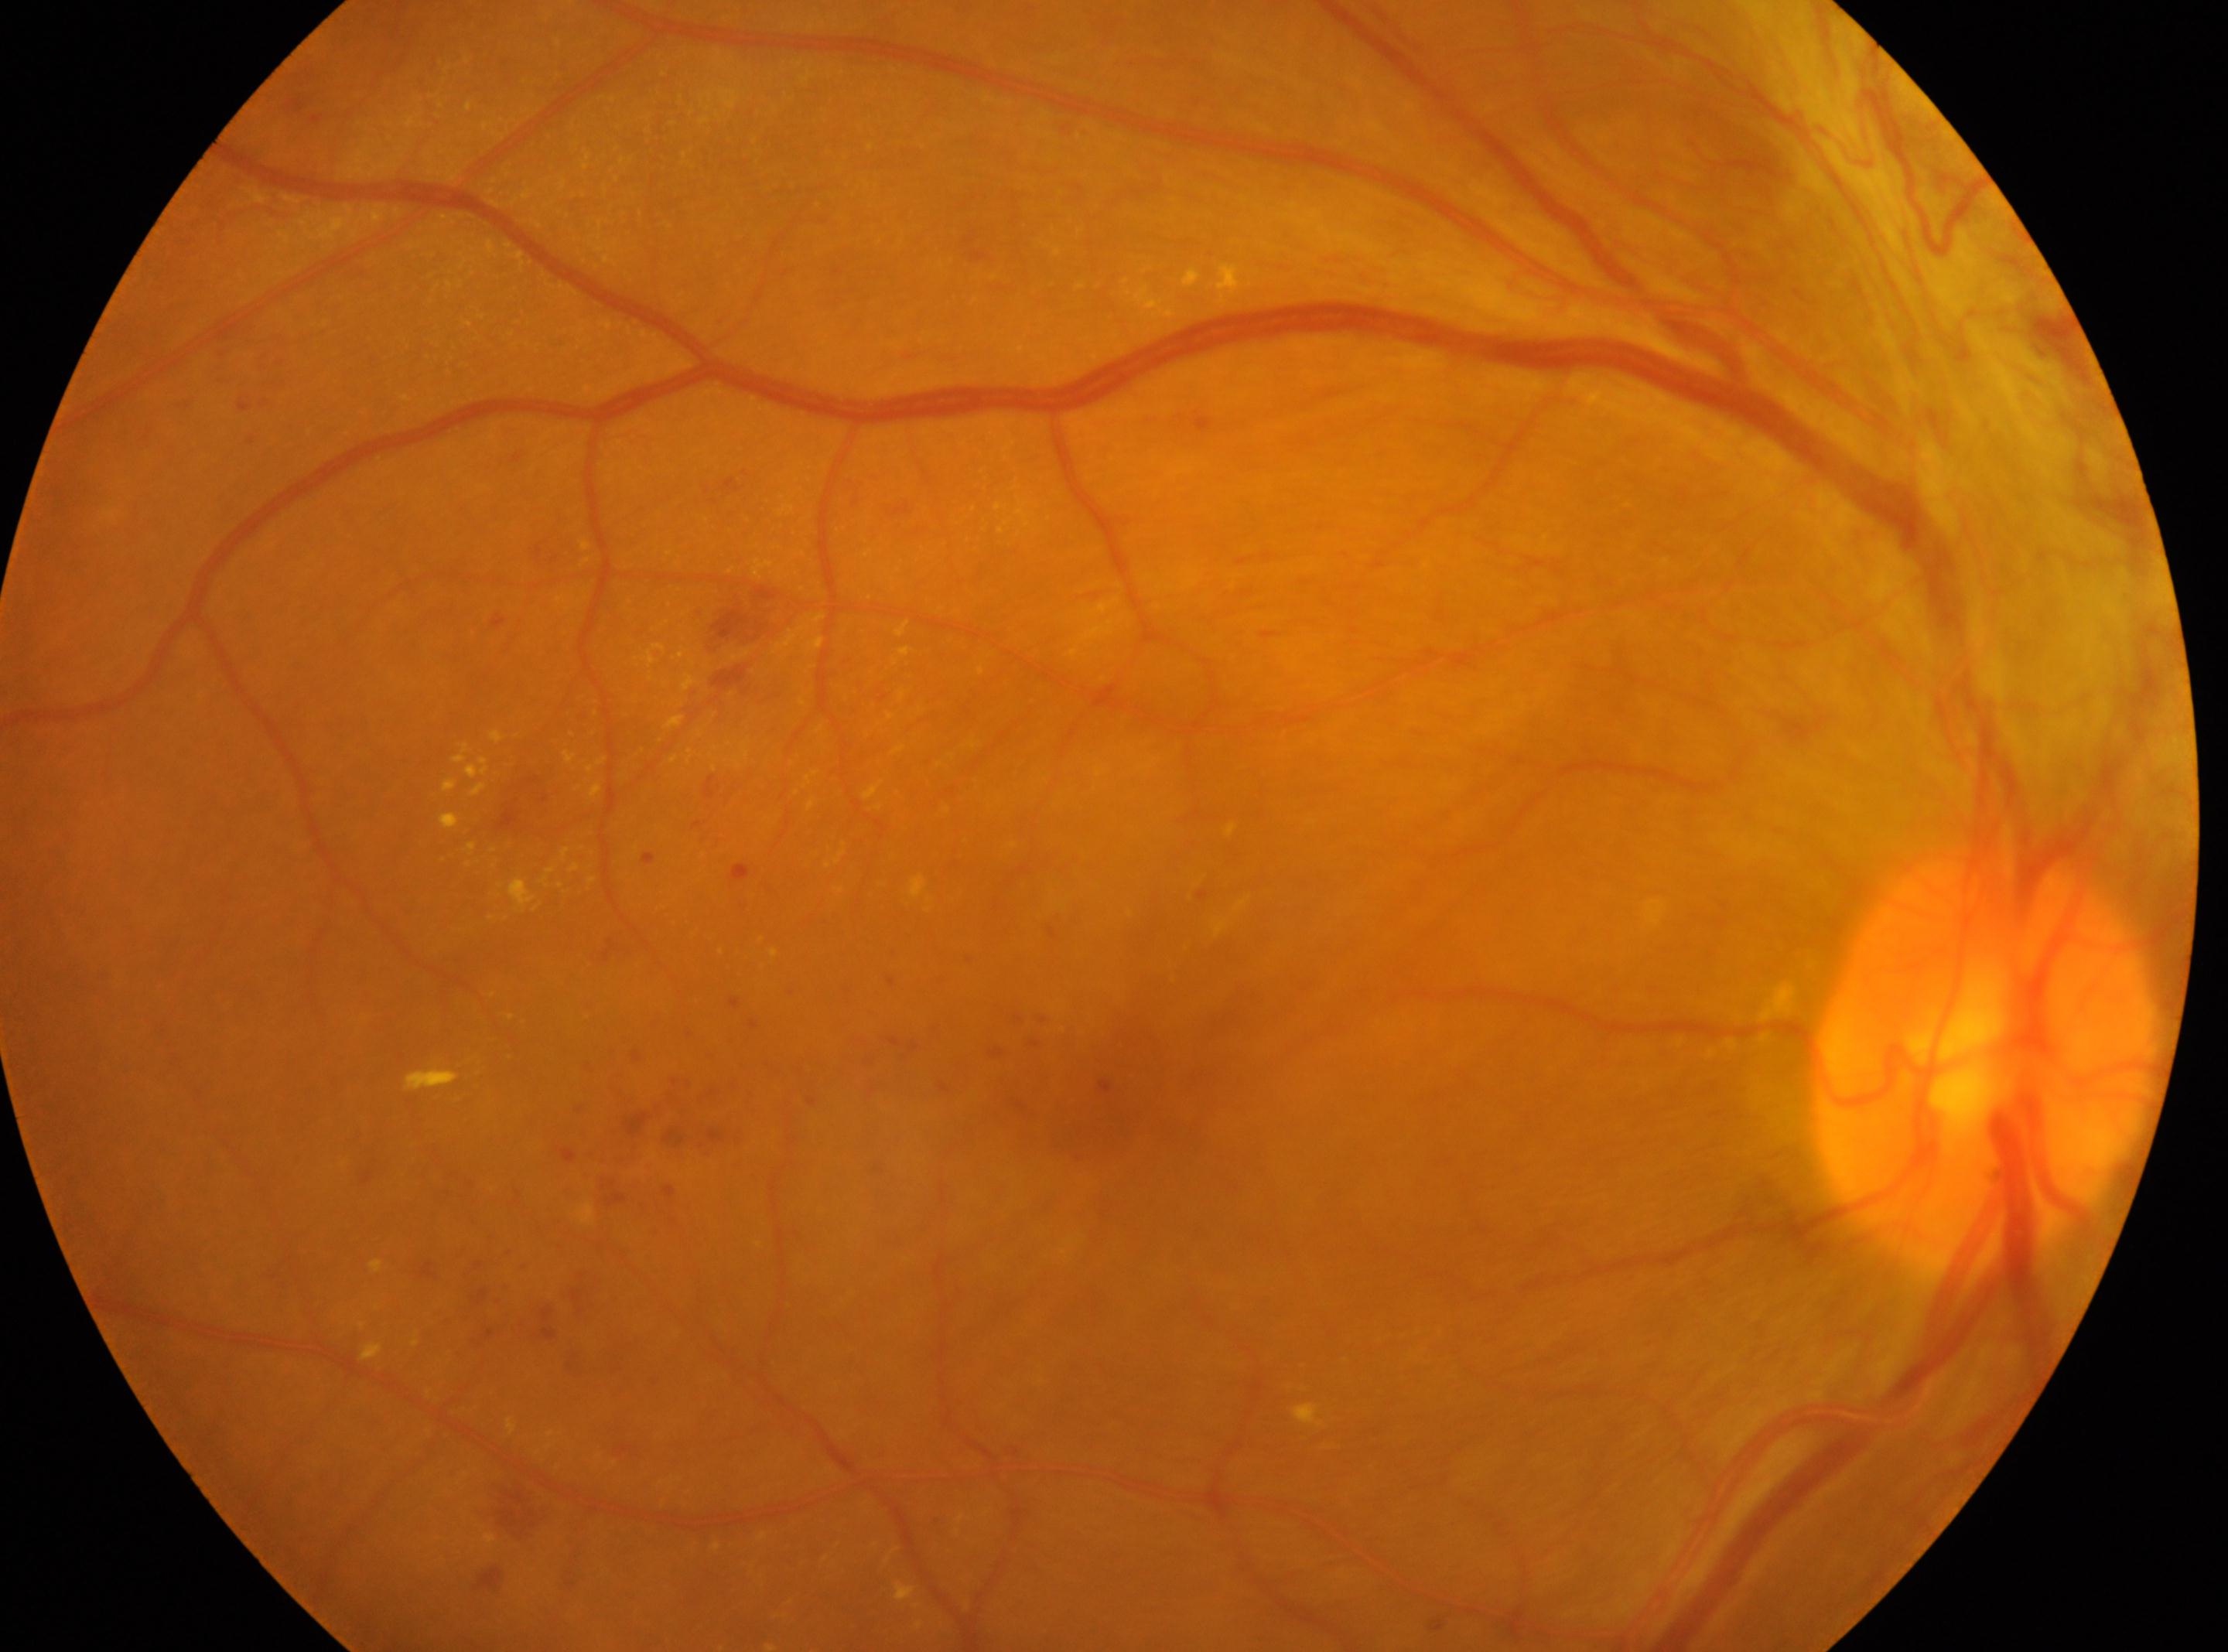

retinopathy grade@PDR (4)
foveal center@1111, 1091
optic nerve head@1984, 1063
OD
proliferative diabetic retinopathy